Dilated-pupil acquisition.
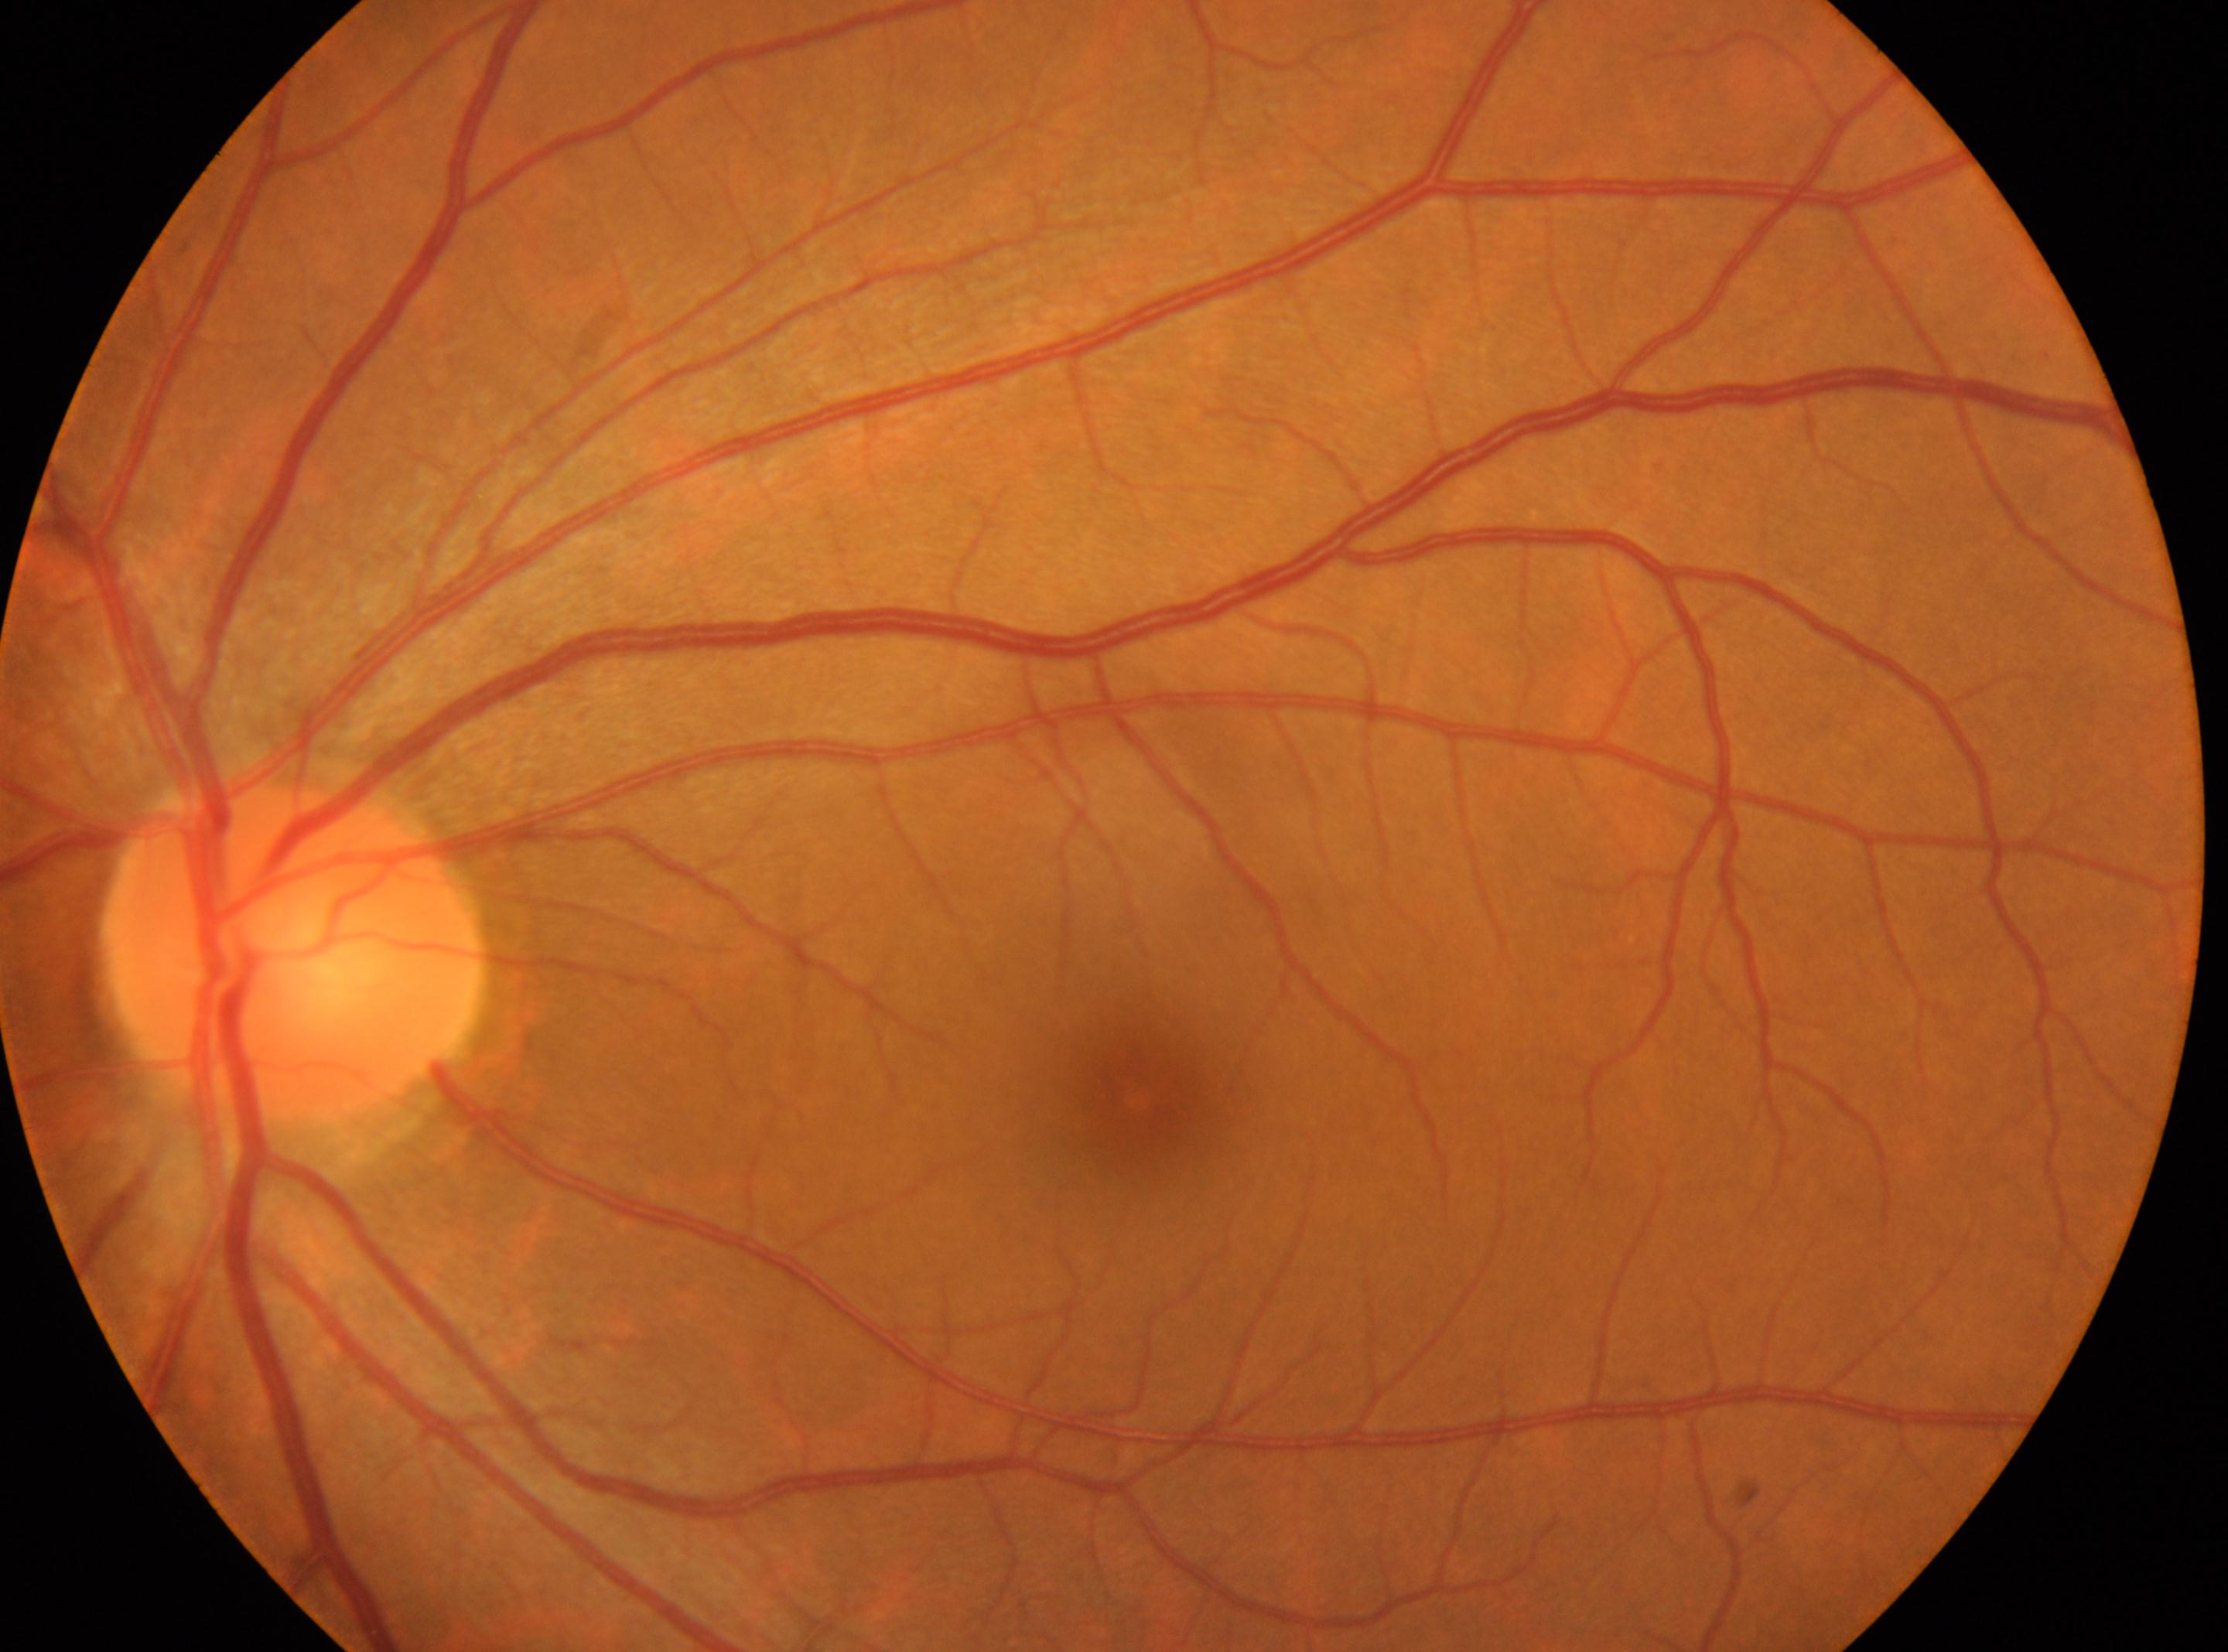
No DR findings. DR stage is no apparent retinopathy (grade 0). Eye: the left eye. Macular center: (1136,1097). The ONH is at (297,950).